Pediatric retinal photograph (wide-field) · 640x480 · Clarity RetCam 3, 130° FOV — 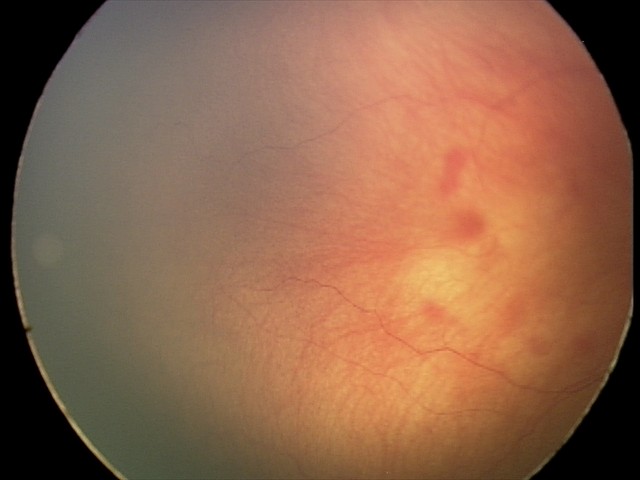
From an examination with diagnosis of retinal hemorrhages.